1240x1240 · infant wide-field retinal image: 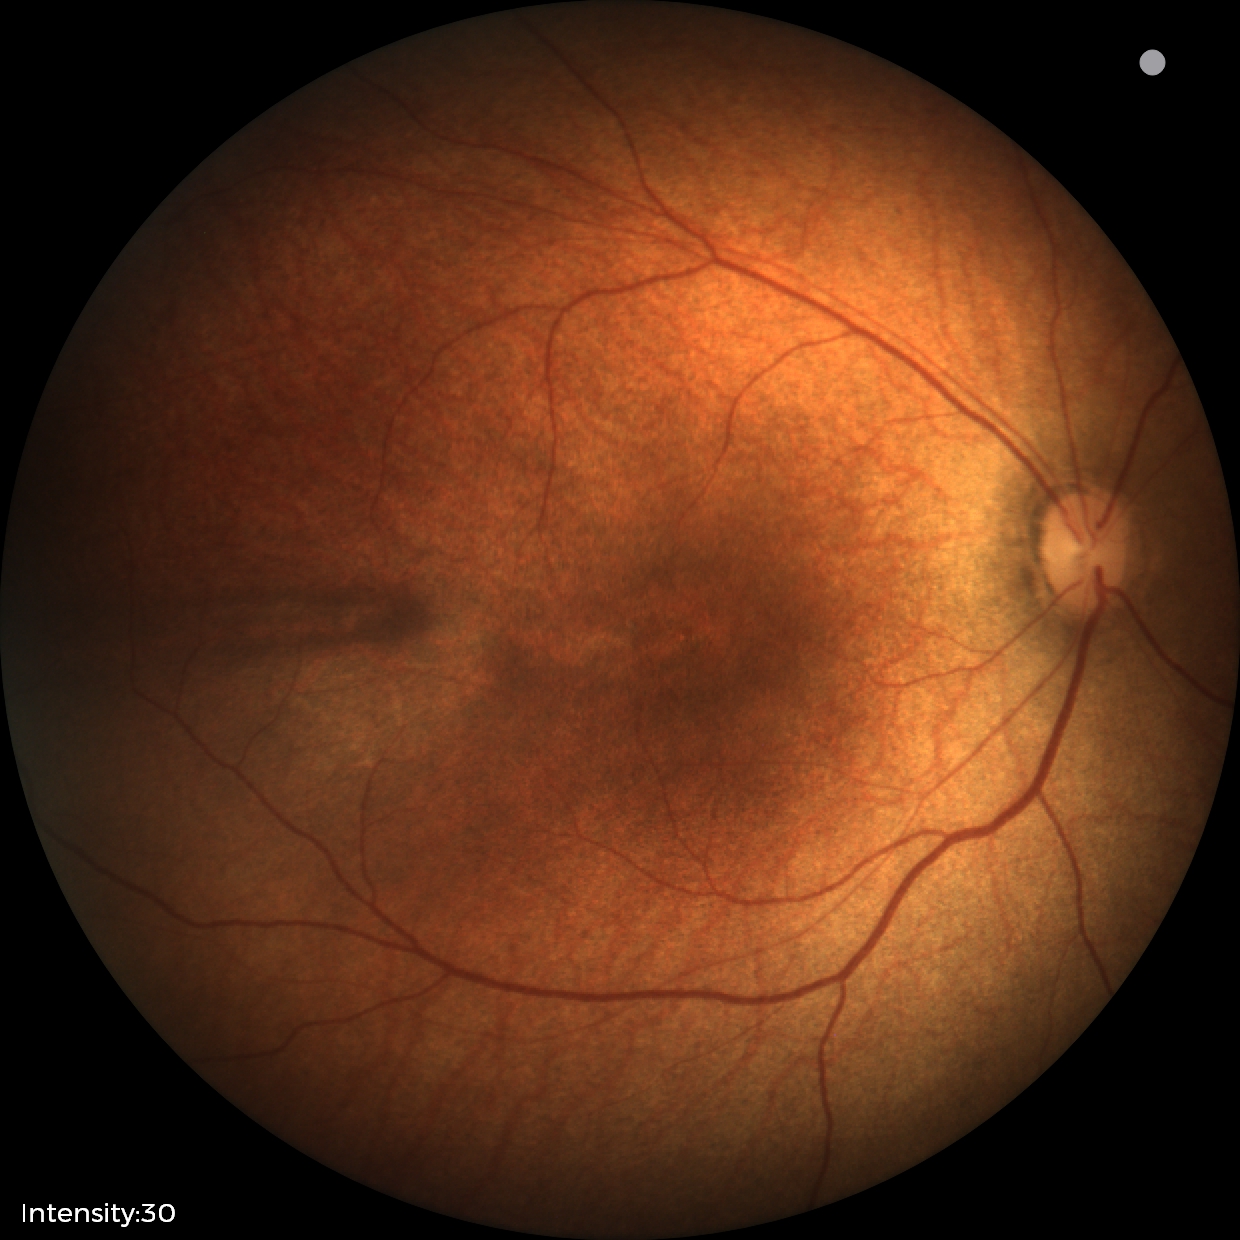

Impression: normal retinal appearance.